45° field of view.
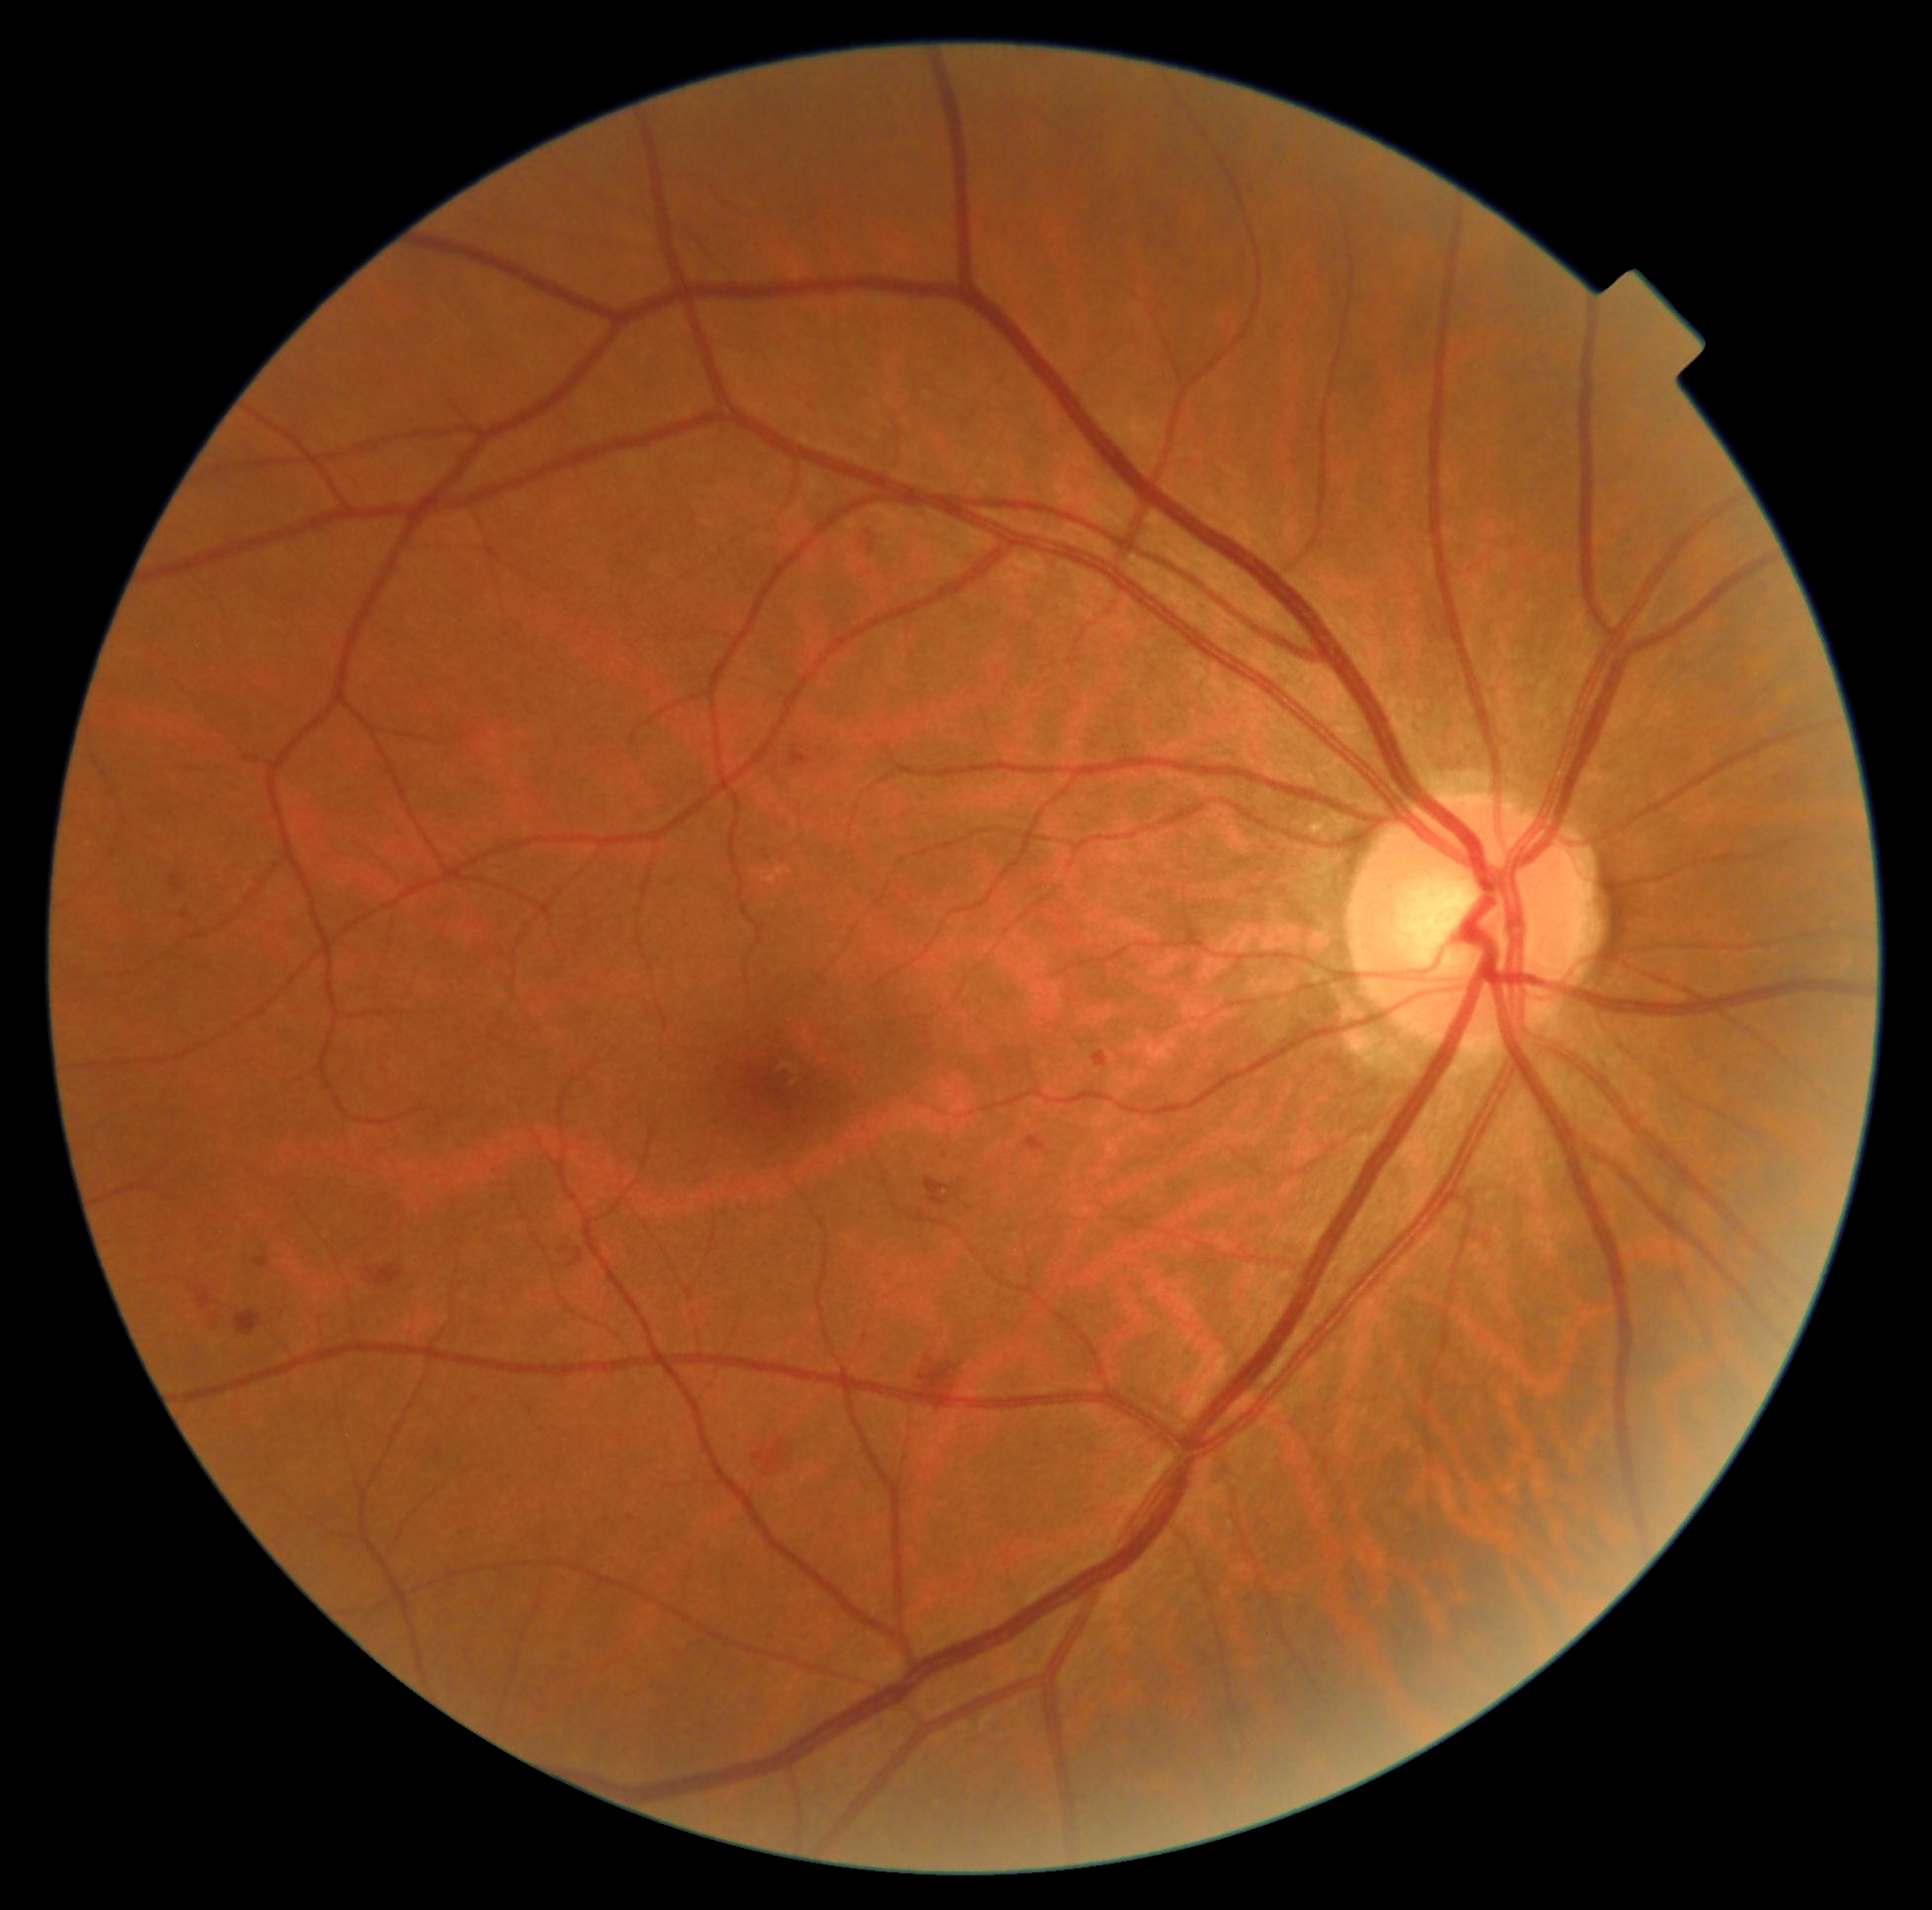
DR grade: 2 (moderate NPDR).